NIDEK AFC-230 · without pupil dilation
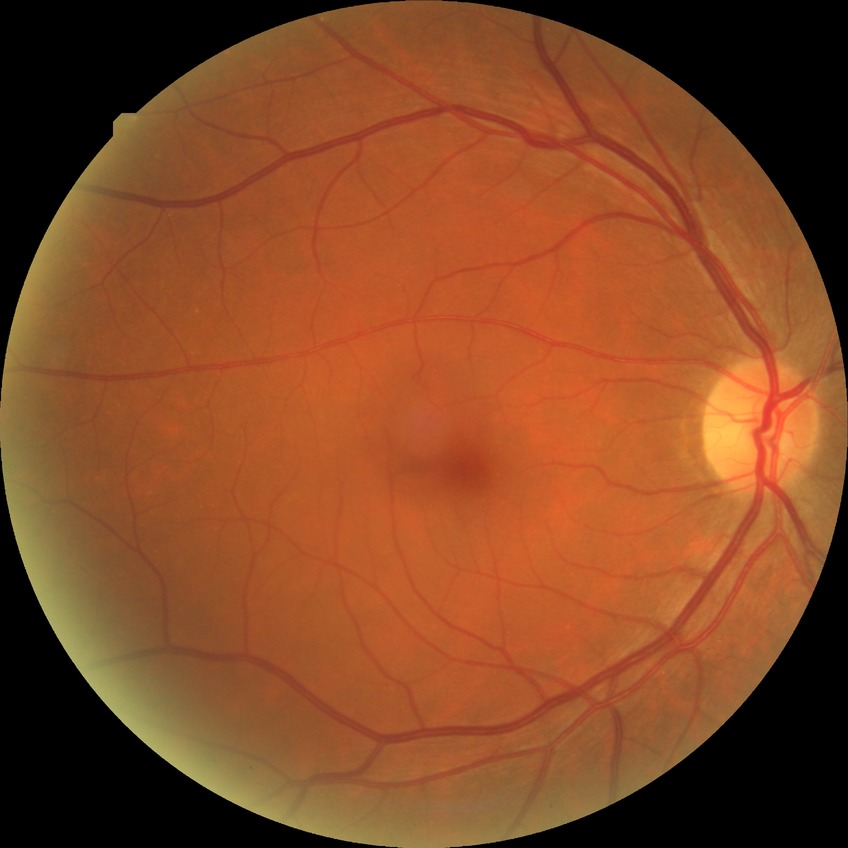
DR severity@NDR.